FOV: 45 degrees:
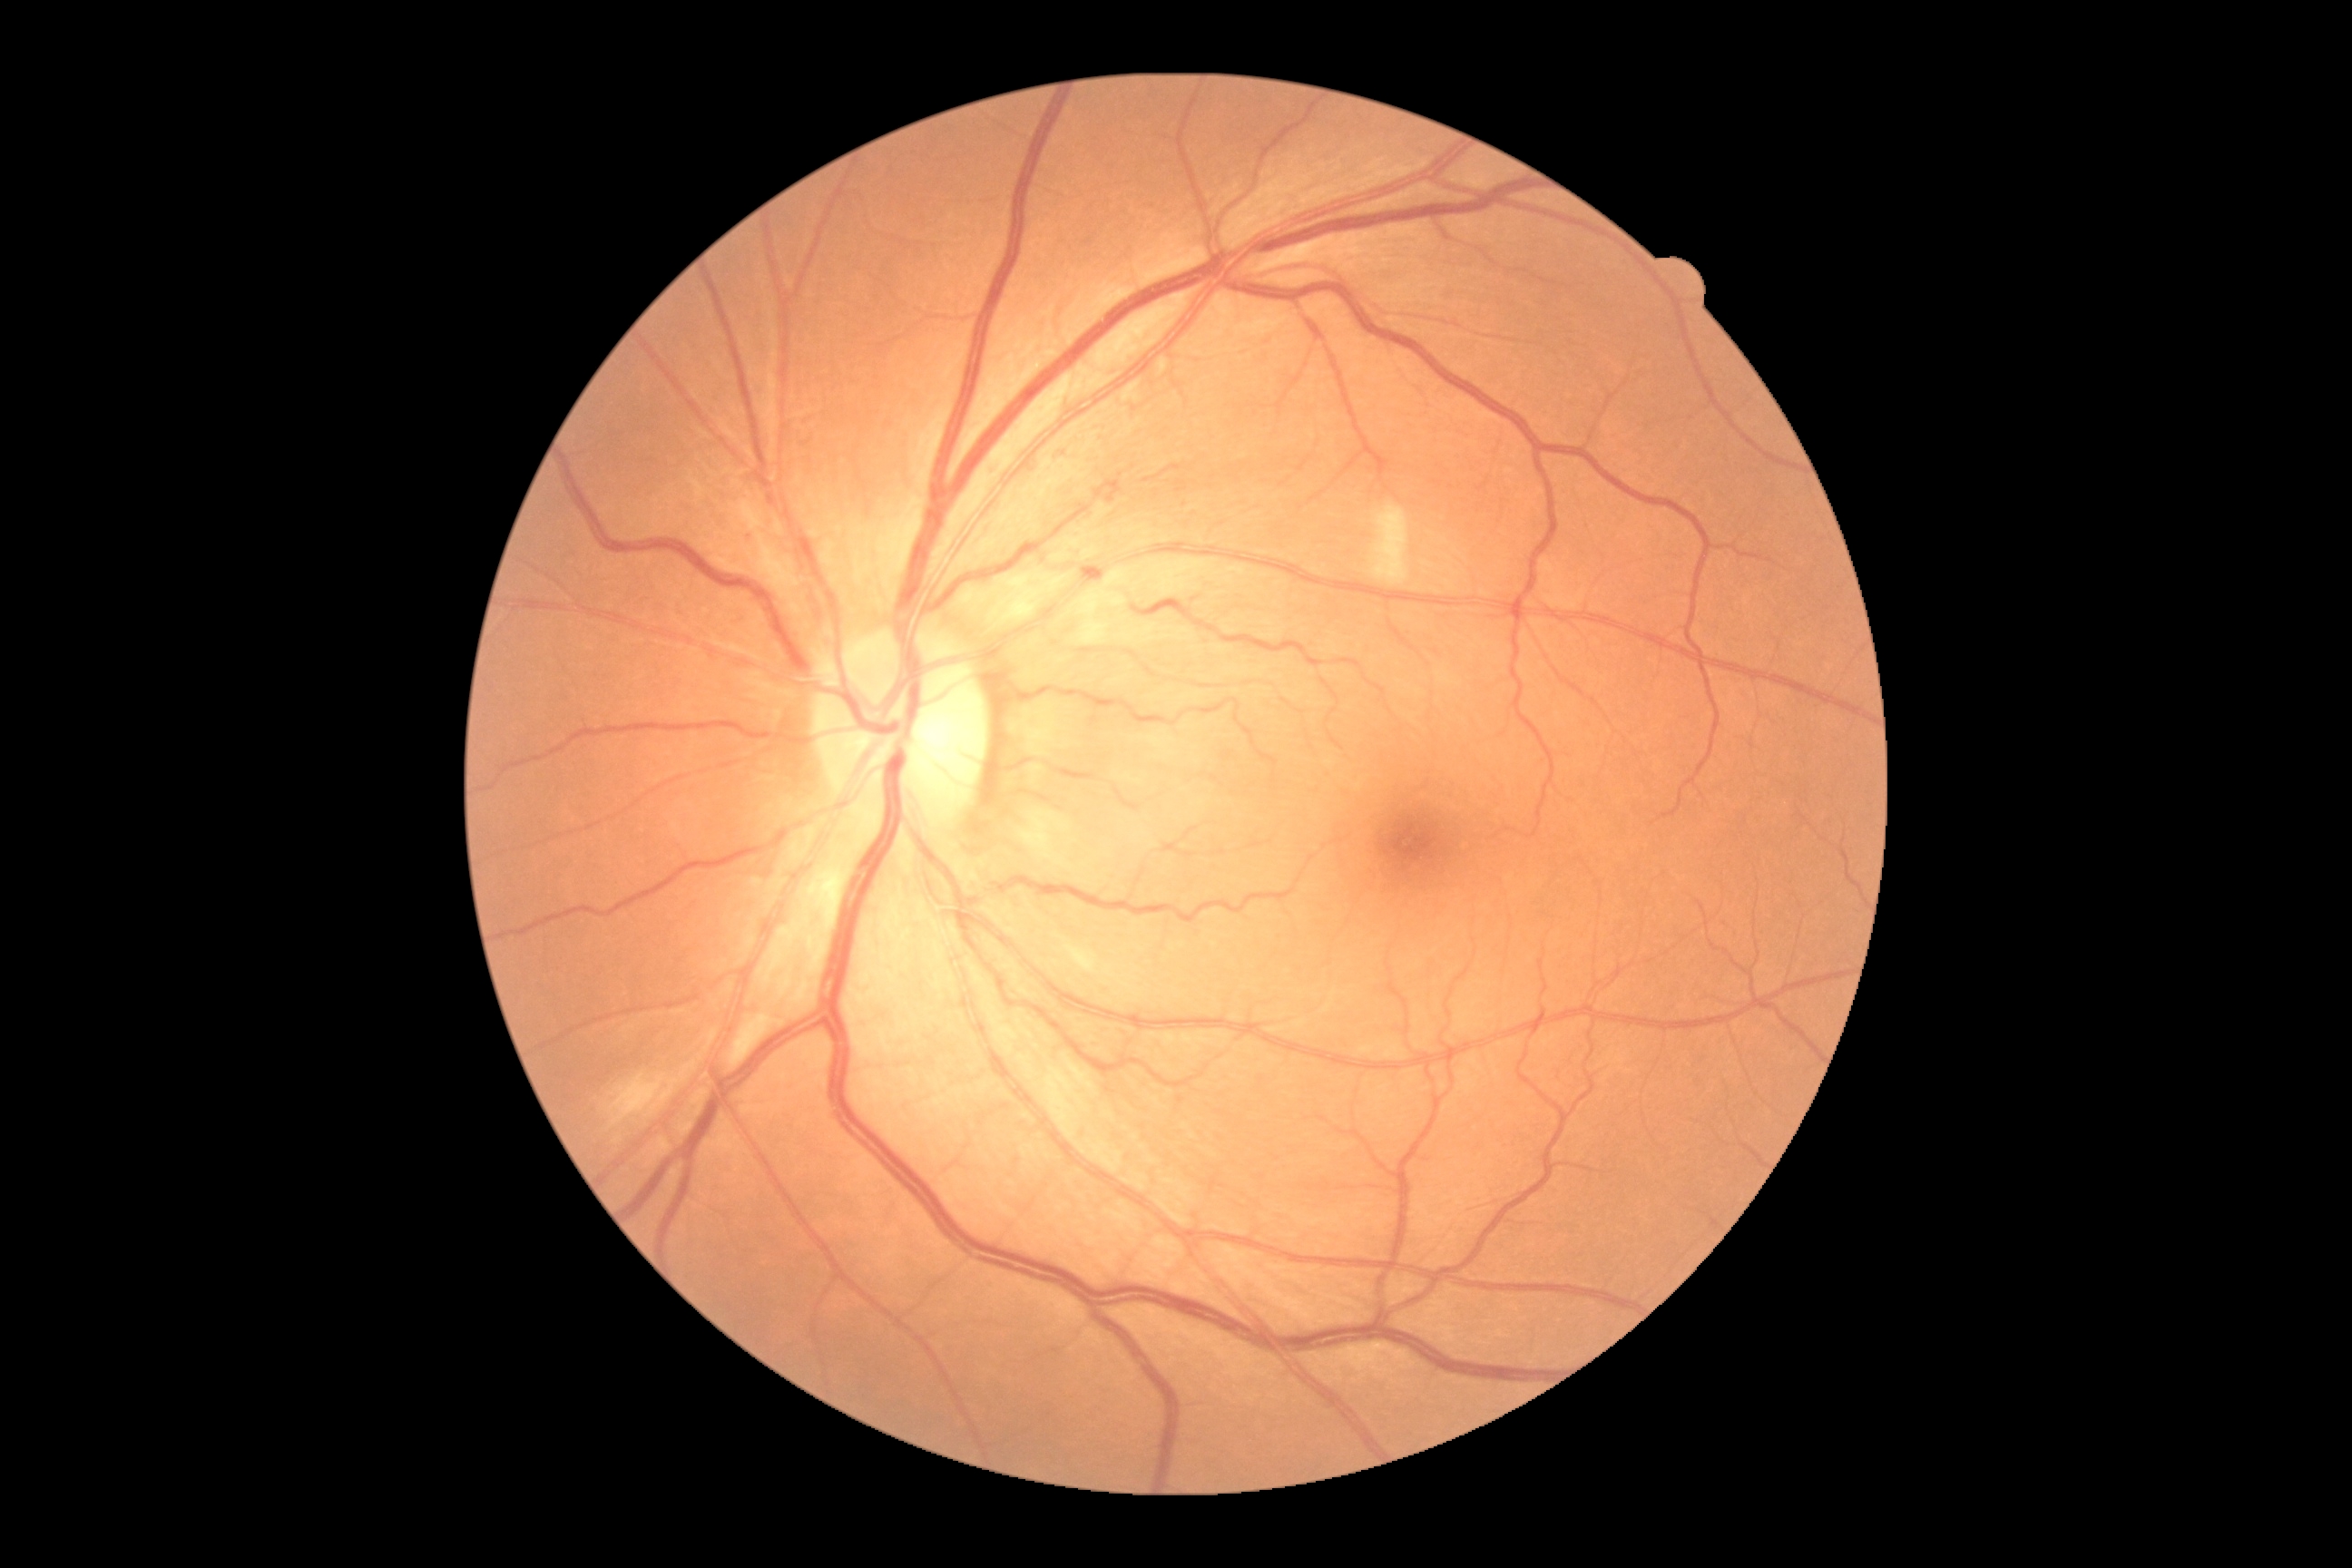 The retinopathy is classified as non-proliferative diabetic retinopathy.
DR is 2/4.